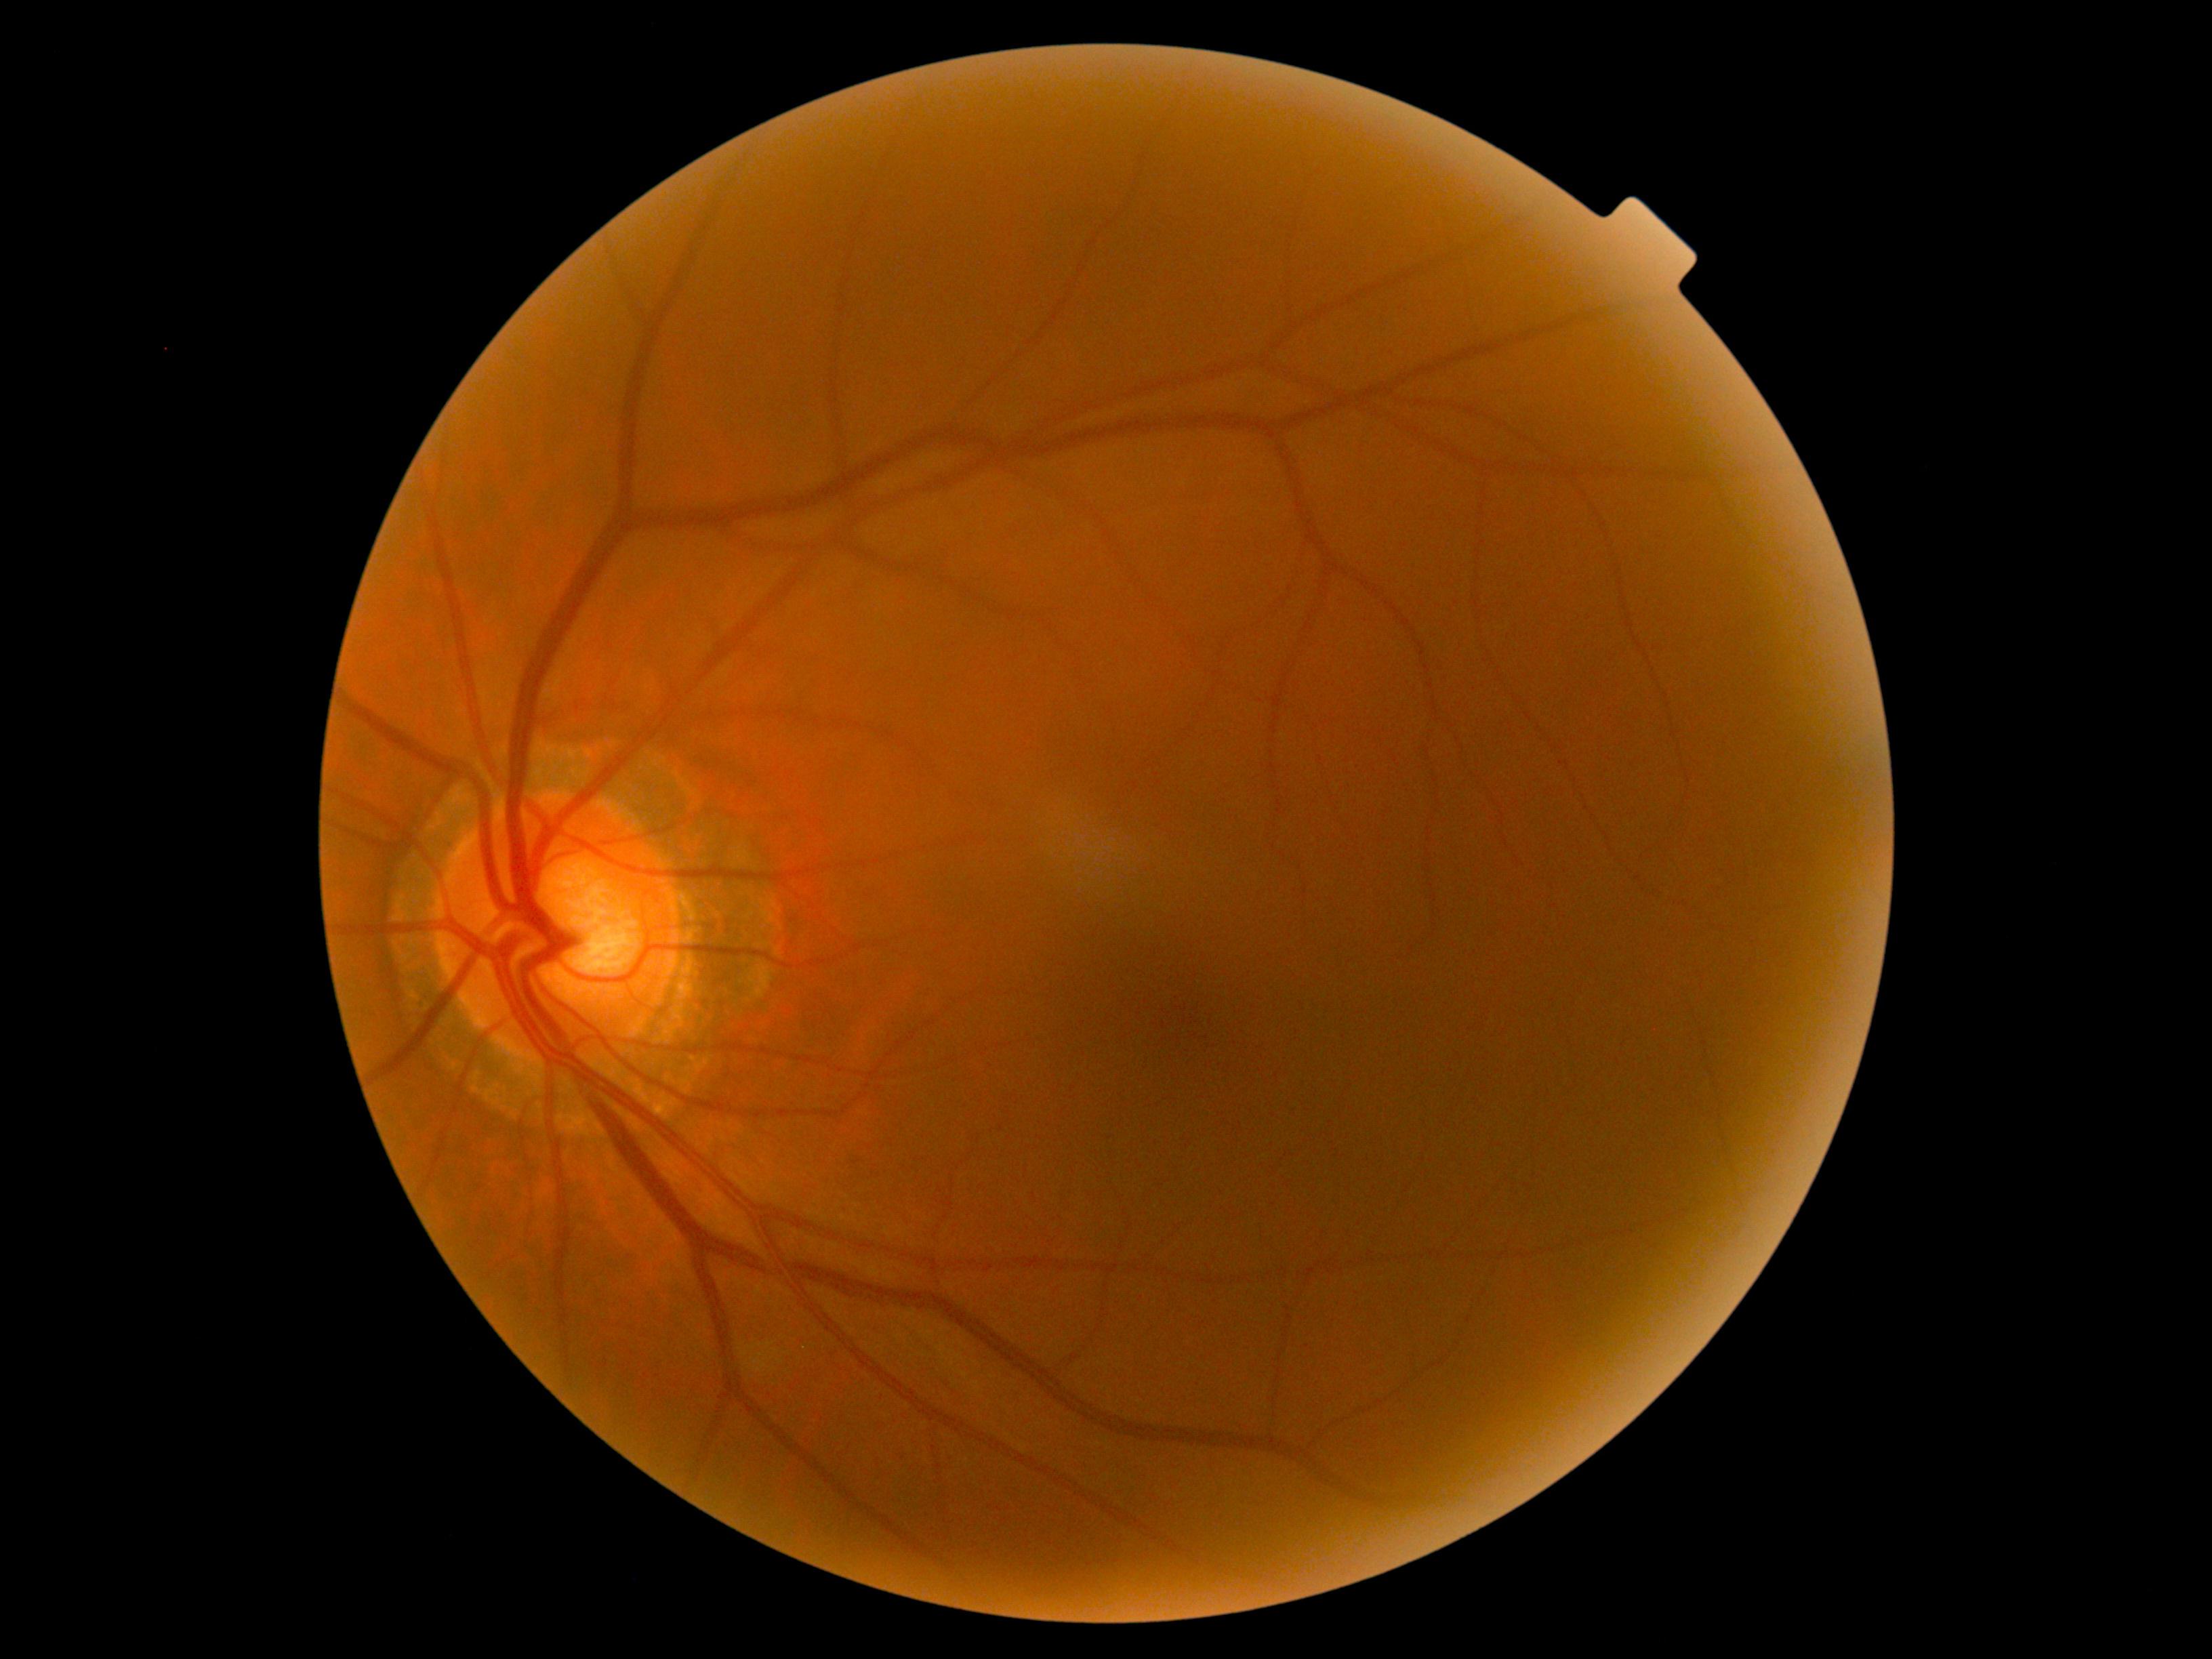
Retinopathy grade is 0.